Modified Davis classification.
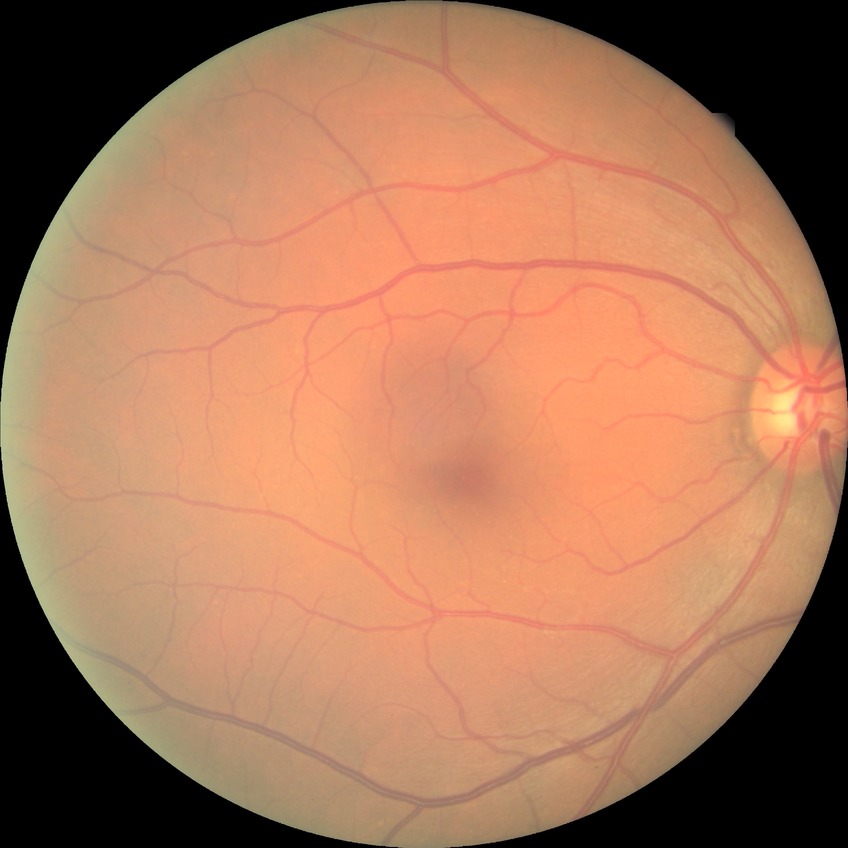 Findings:
- Davis stage: NDR